45° FOV: 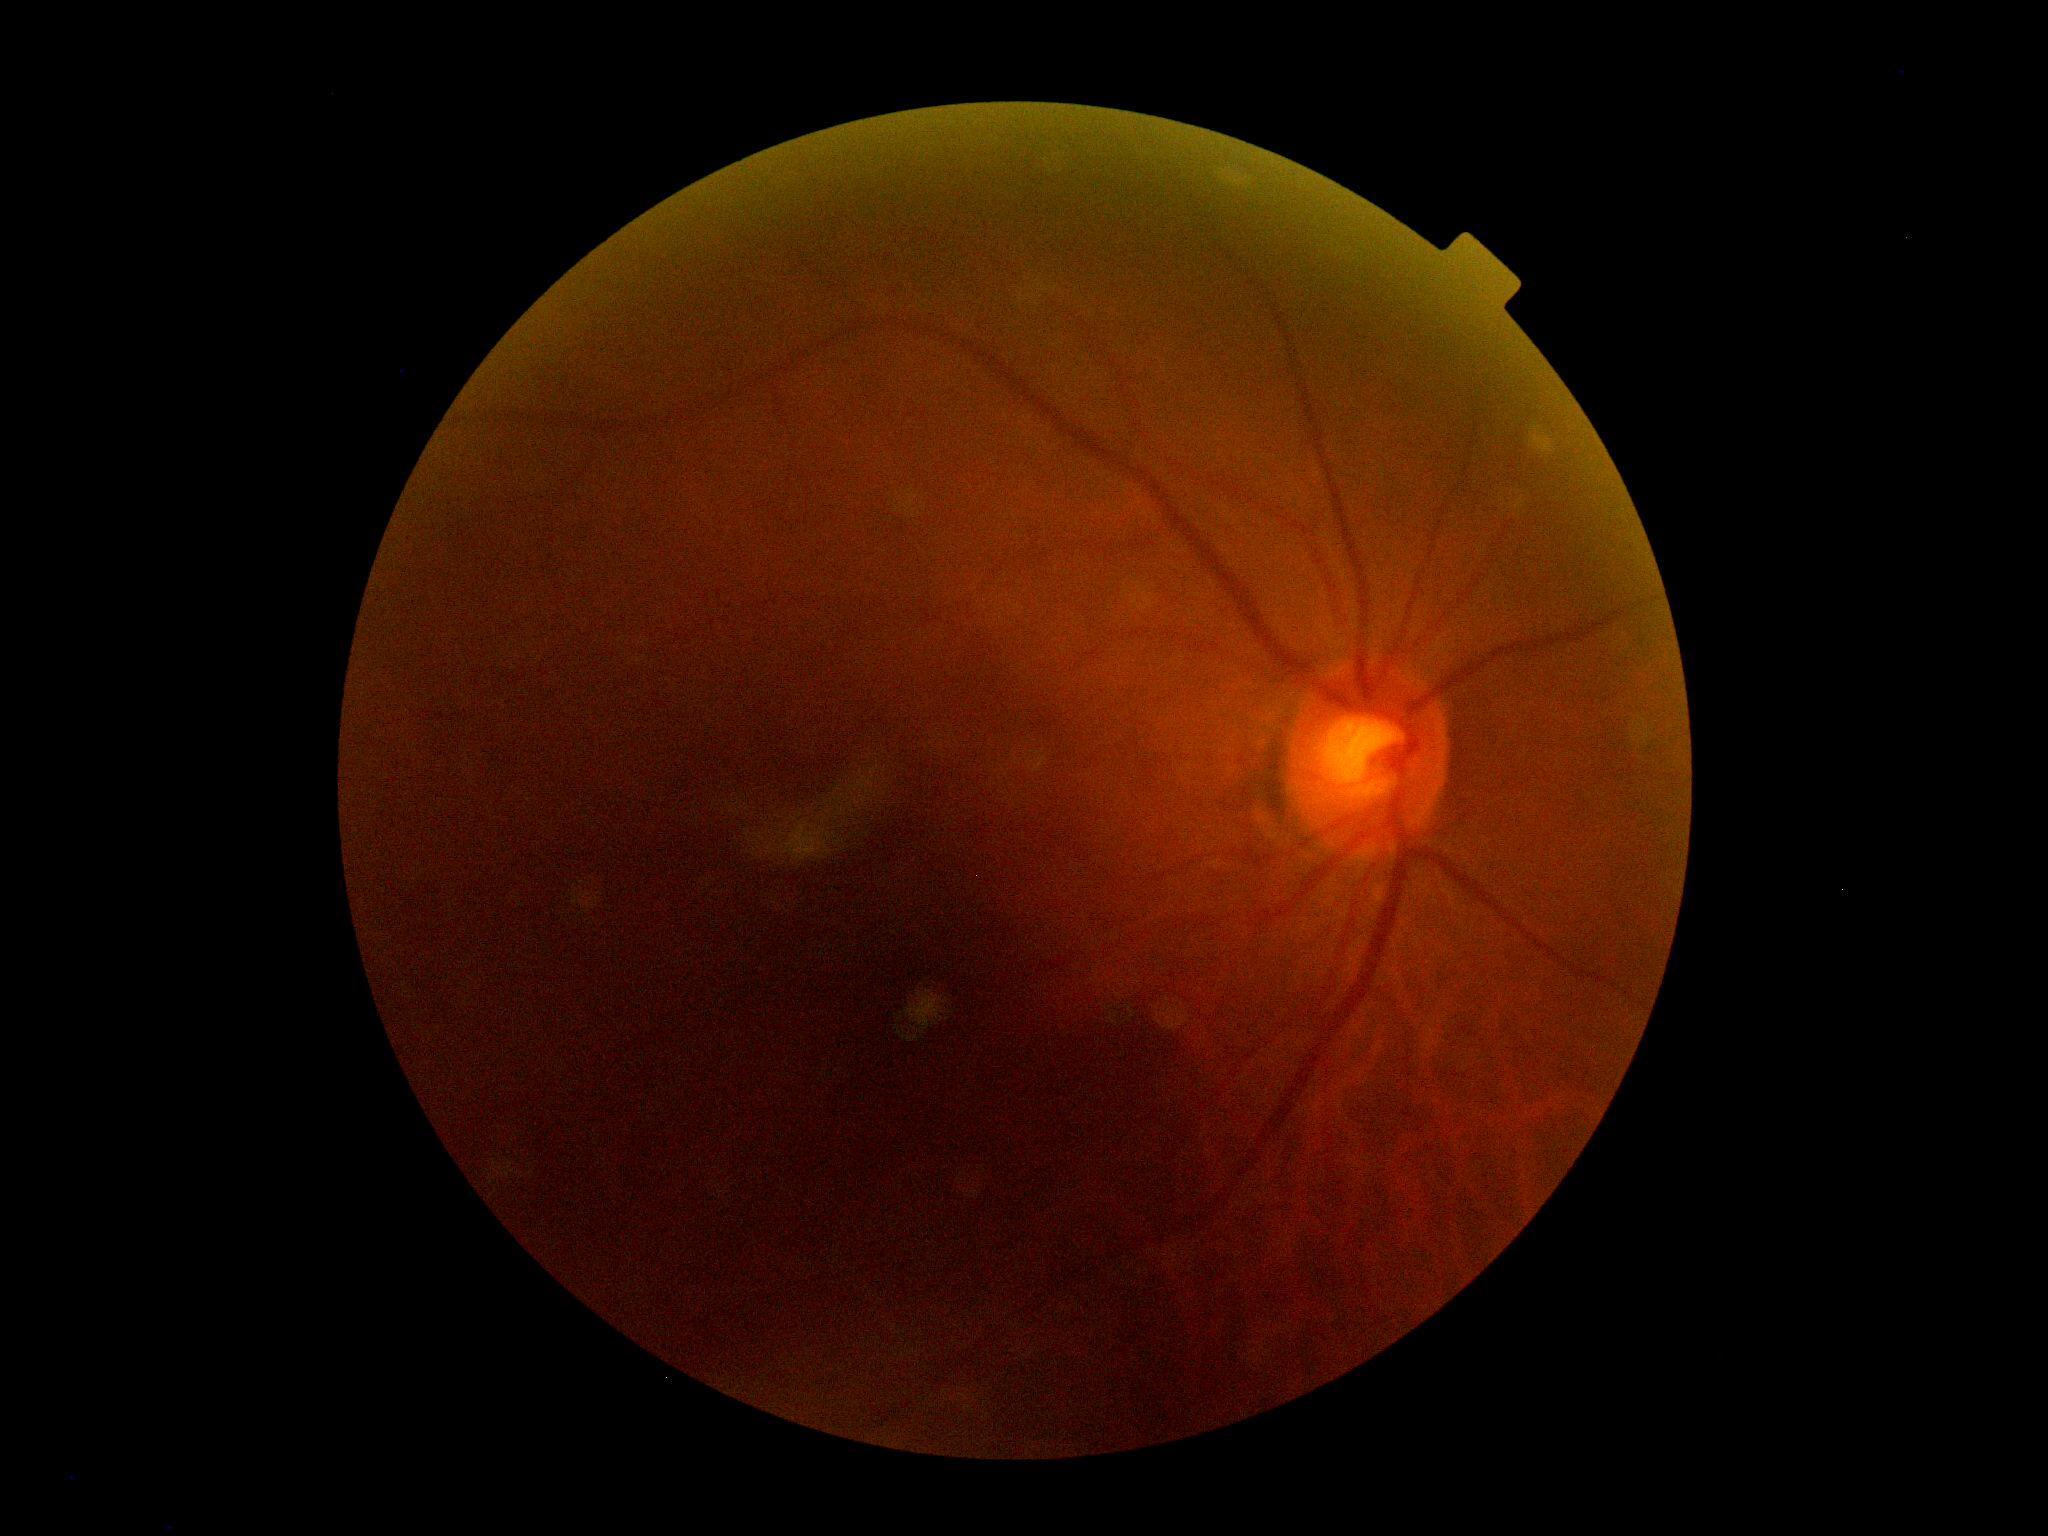 DR impression@negative for DR; DR grade@0.